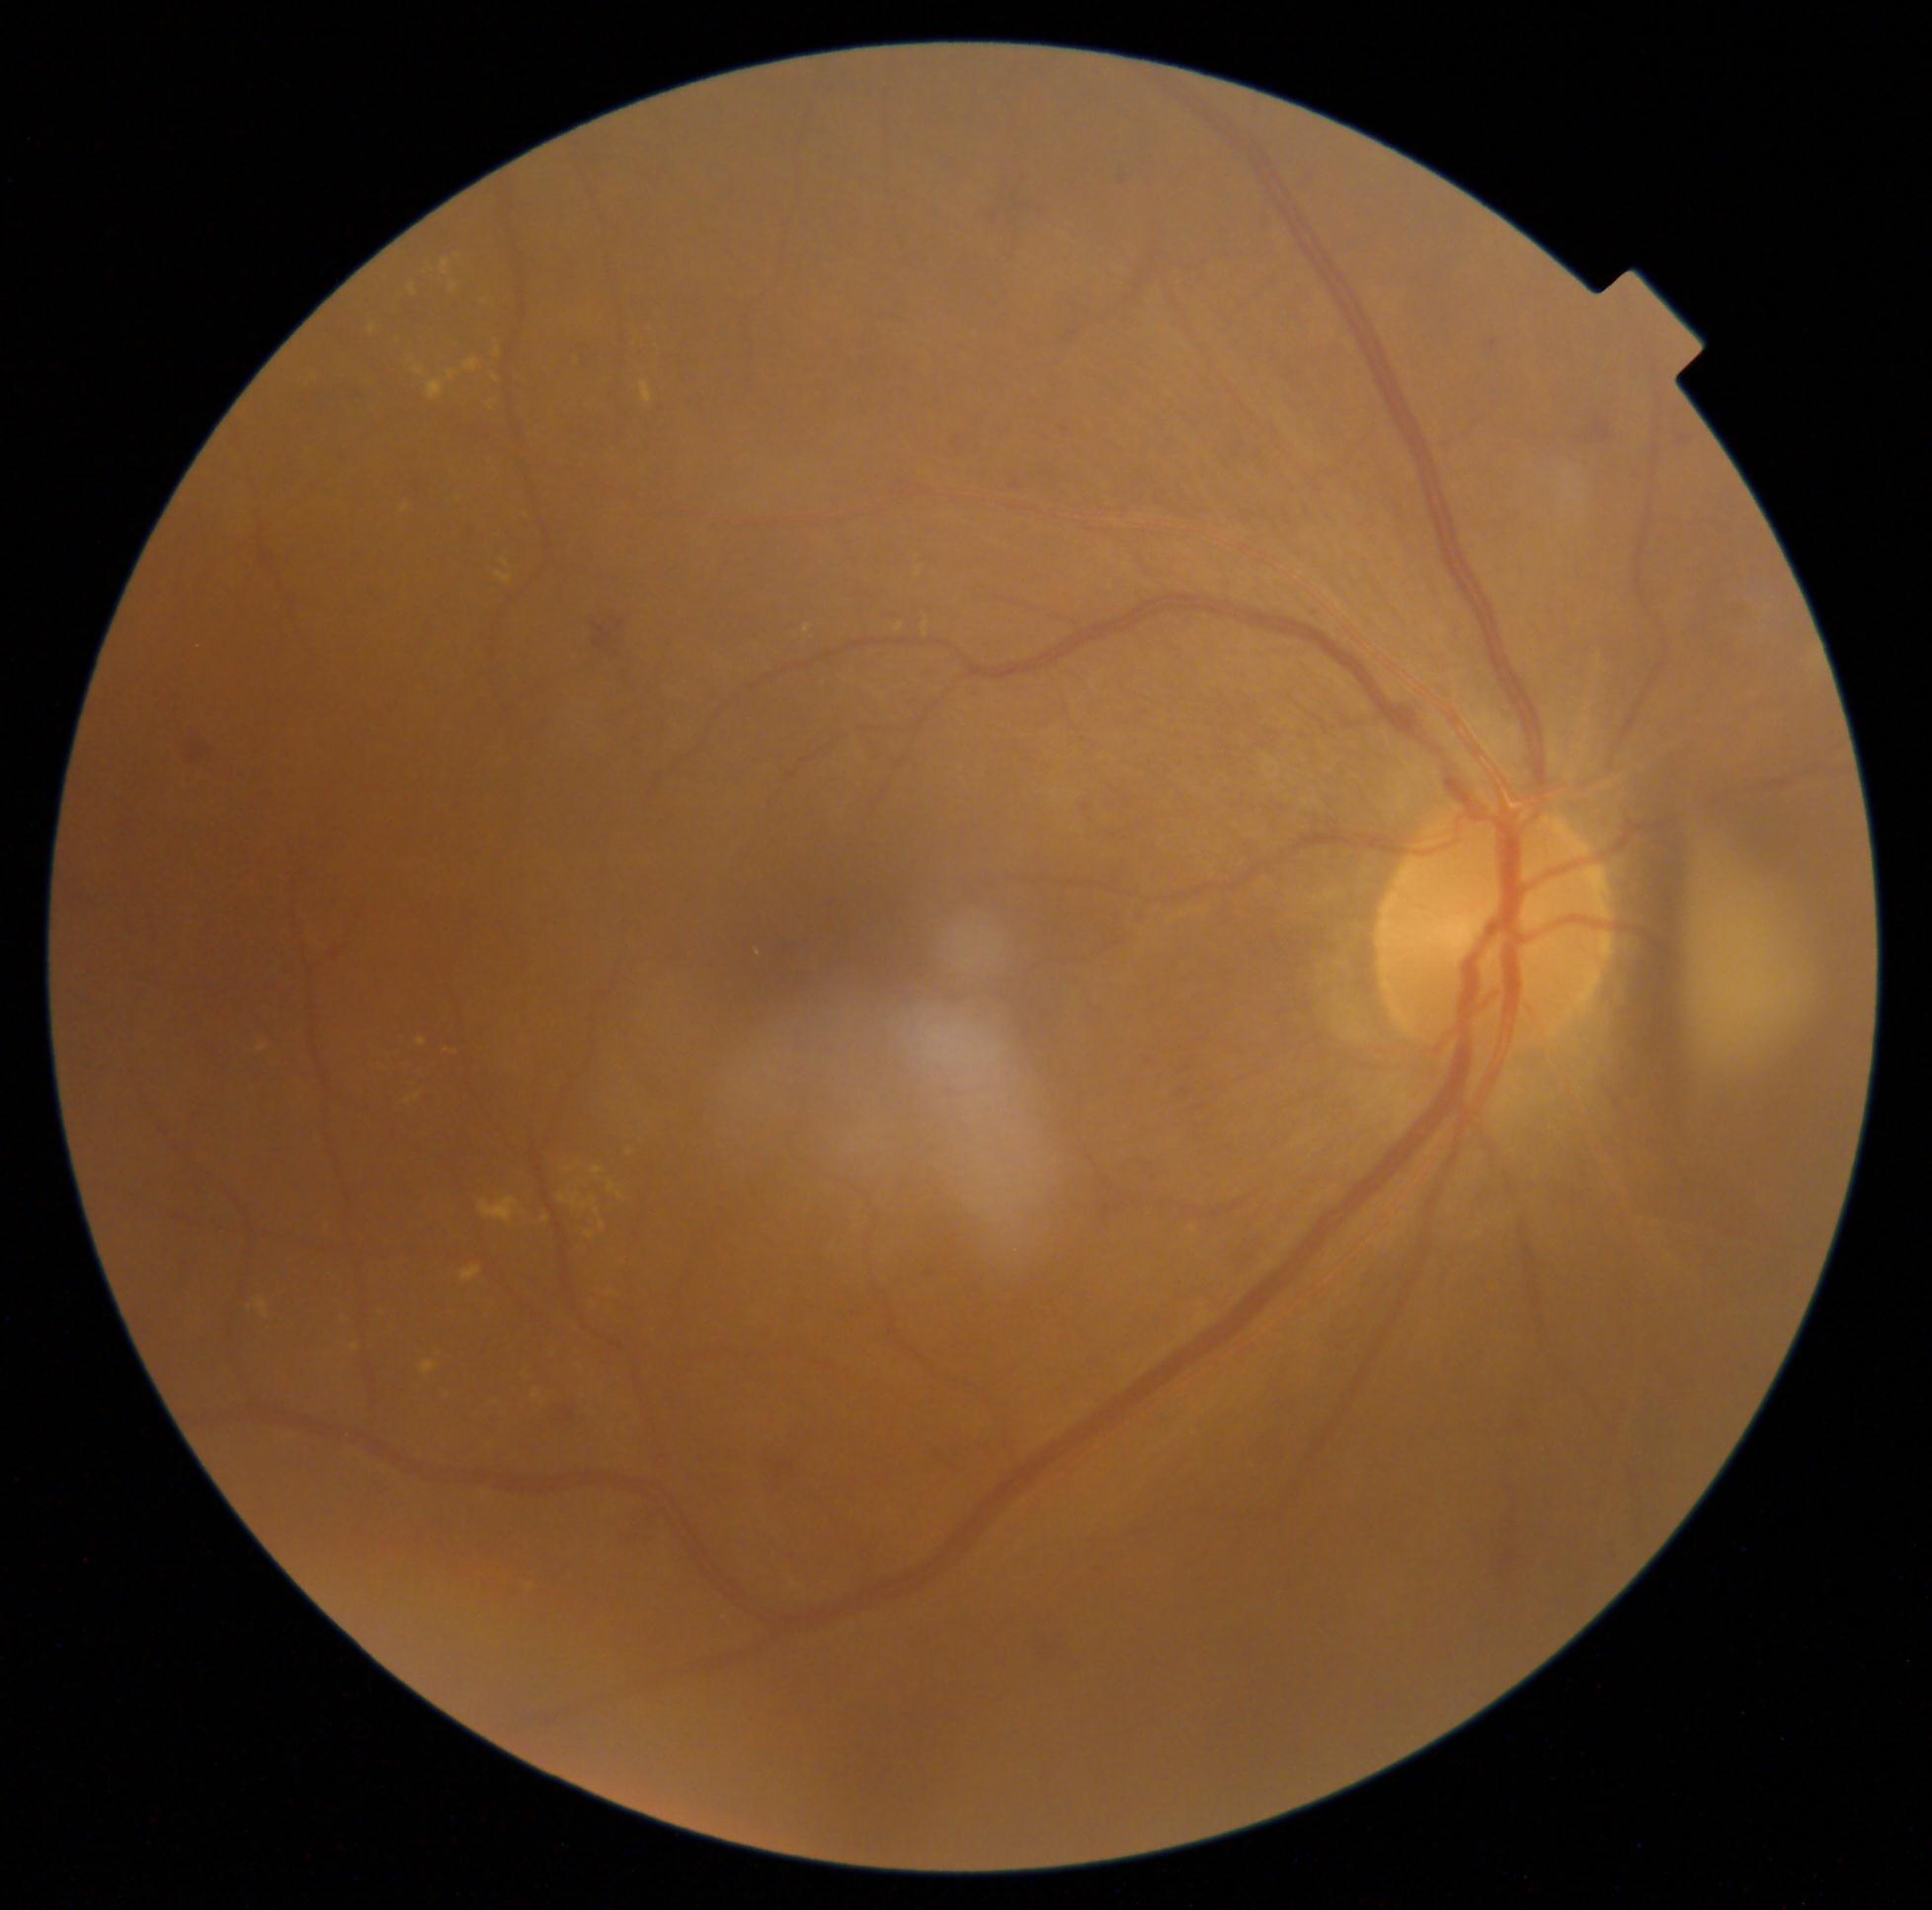 Diabetic retinopathy severity is moderate NPDR (grade 2)
Selected lesions:
hard exudates (partial): <box>502,560,510,567</box> | <box>519,1369,532,1381</box> | <box>442,260,450,276</box> | <box>804,624,812,633</box> | <box>446,370,457,381</box> | <box>418,1038,427,1047</box> | <box>896,622,903,632</box> | <box>427,379,444,401</box> | <box>464,359,479,372</box> | <box>609,1182,616,1193</box> | <box>601,1222,605,1231</box> | <box>257,1301,270,1318</box>
Hard exudates (small, approximate centers) near <point>545, 1219</point> | <point>611, 1293</point> | <point>919, 574</point> | <point>356, 1348</point> | <point>323, 1229</point>